Phoenix ICON, 100° FOV; 1240 by 1240 pixels; pediatric retinal photograph (wide-field) — 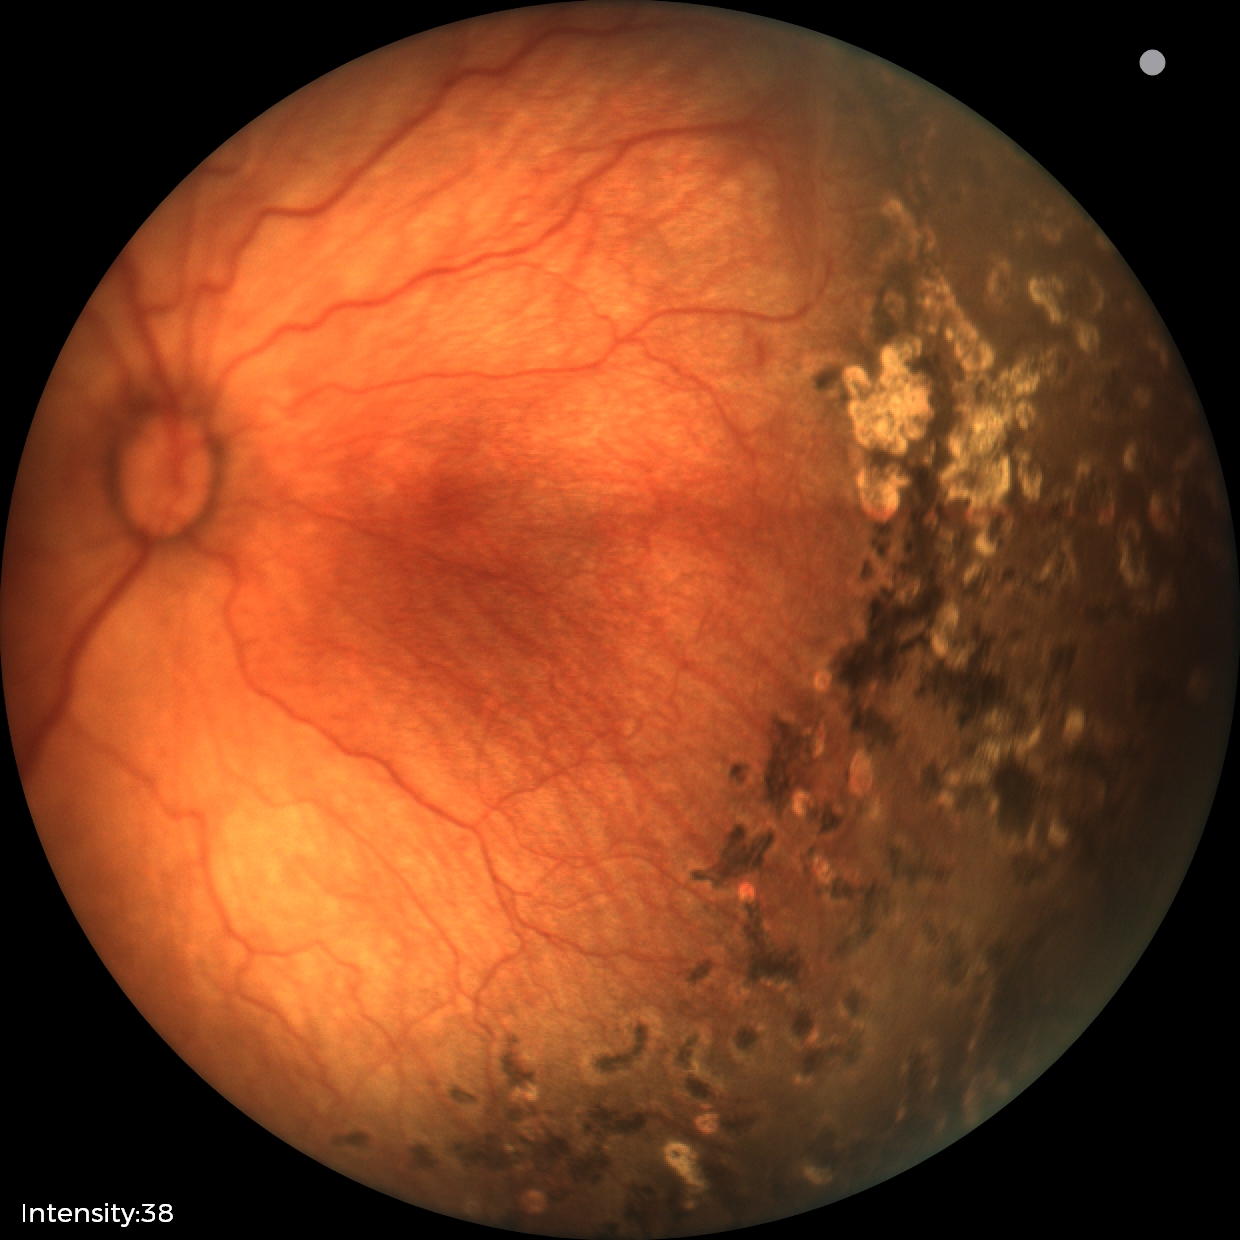 Screening: status post retinopathy of prematurity (ROP).